2048x1536px
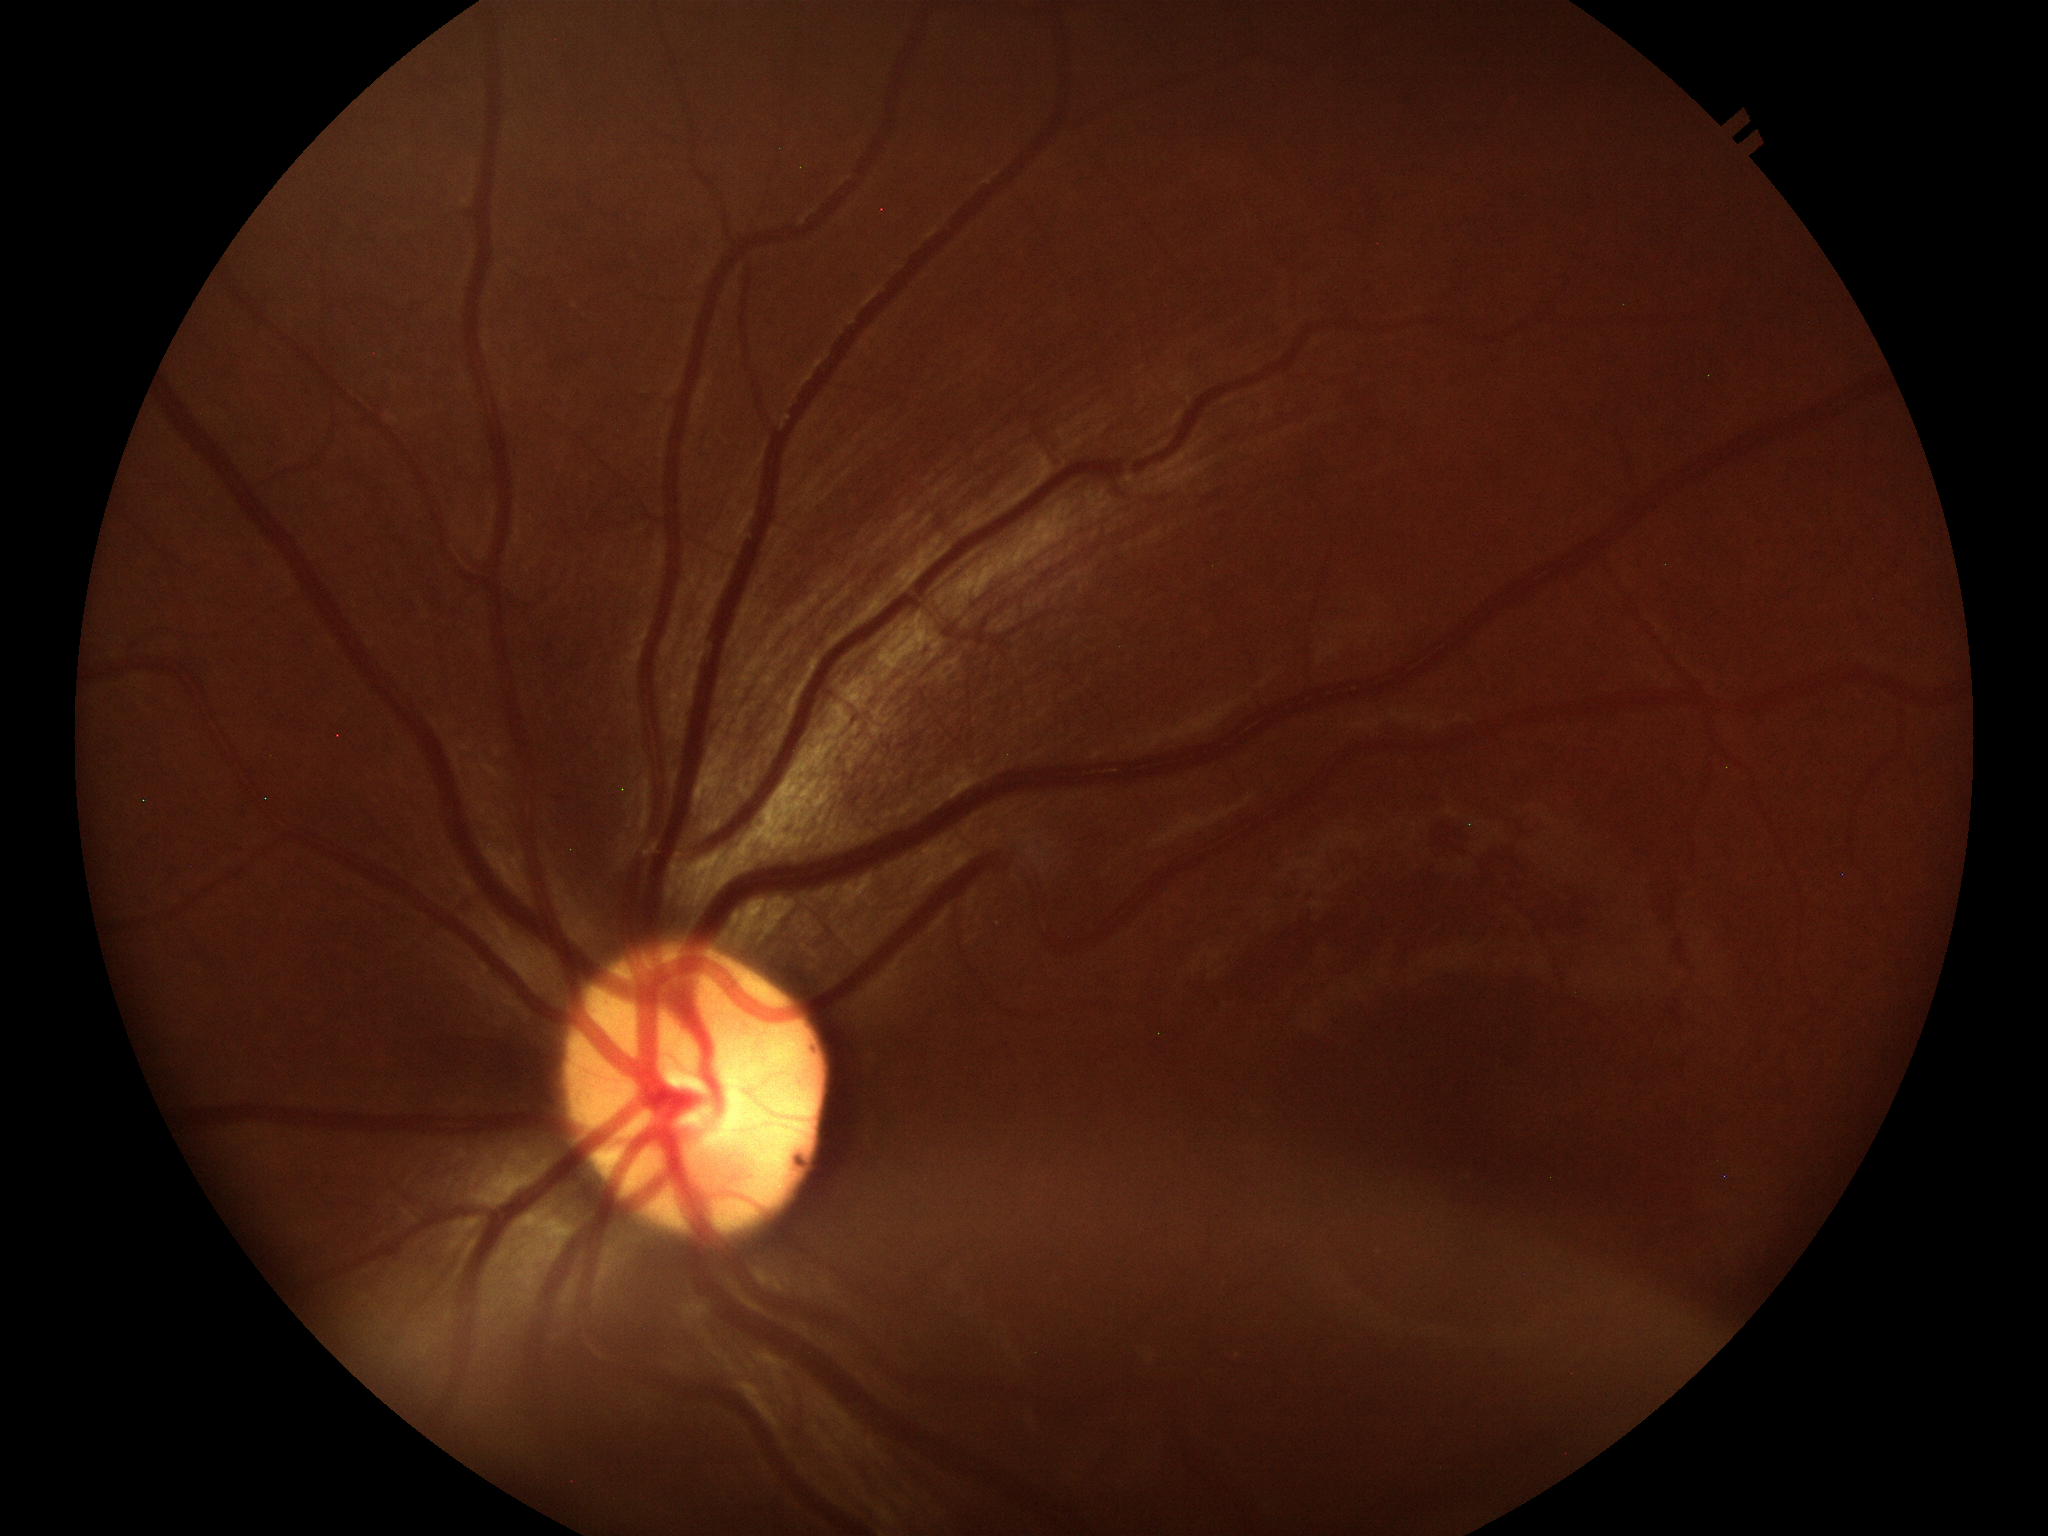

Vertical cup-to-disc ratio (VCDR) is 0.49.
Glaucoma decision: not suspect.